848 x 848 pixels: 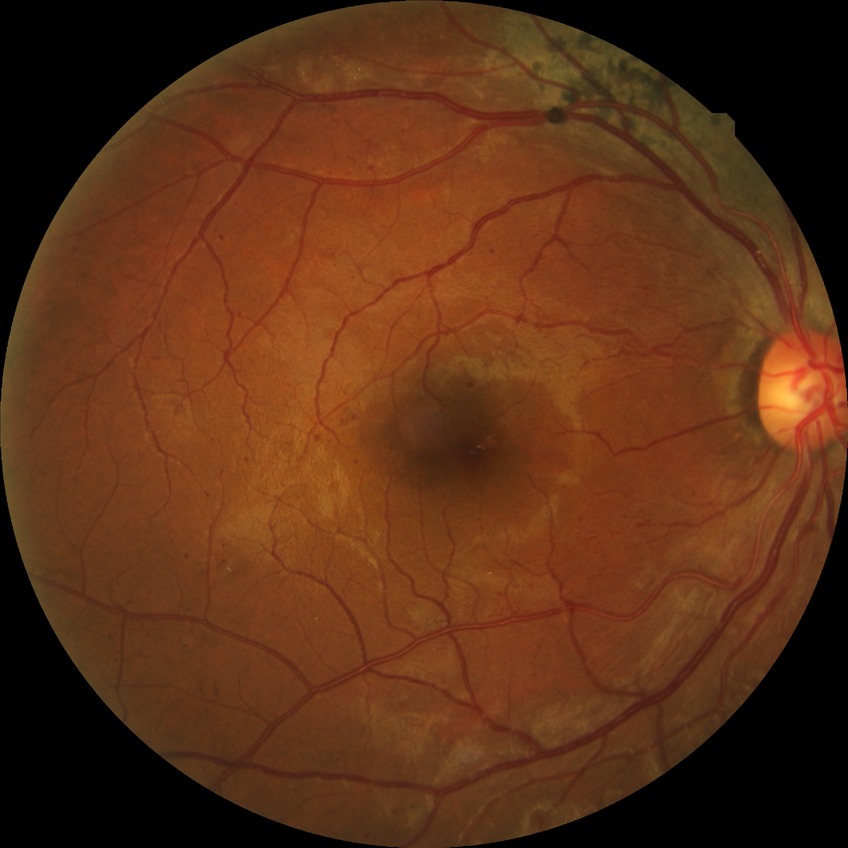 DR class: non-proliferative diabetic retinopathy; diabetic retinopathy (DR): pre-proliferative diabetic retinopathy (PPDR).